UWF retinal mosaic — 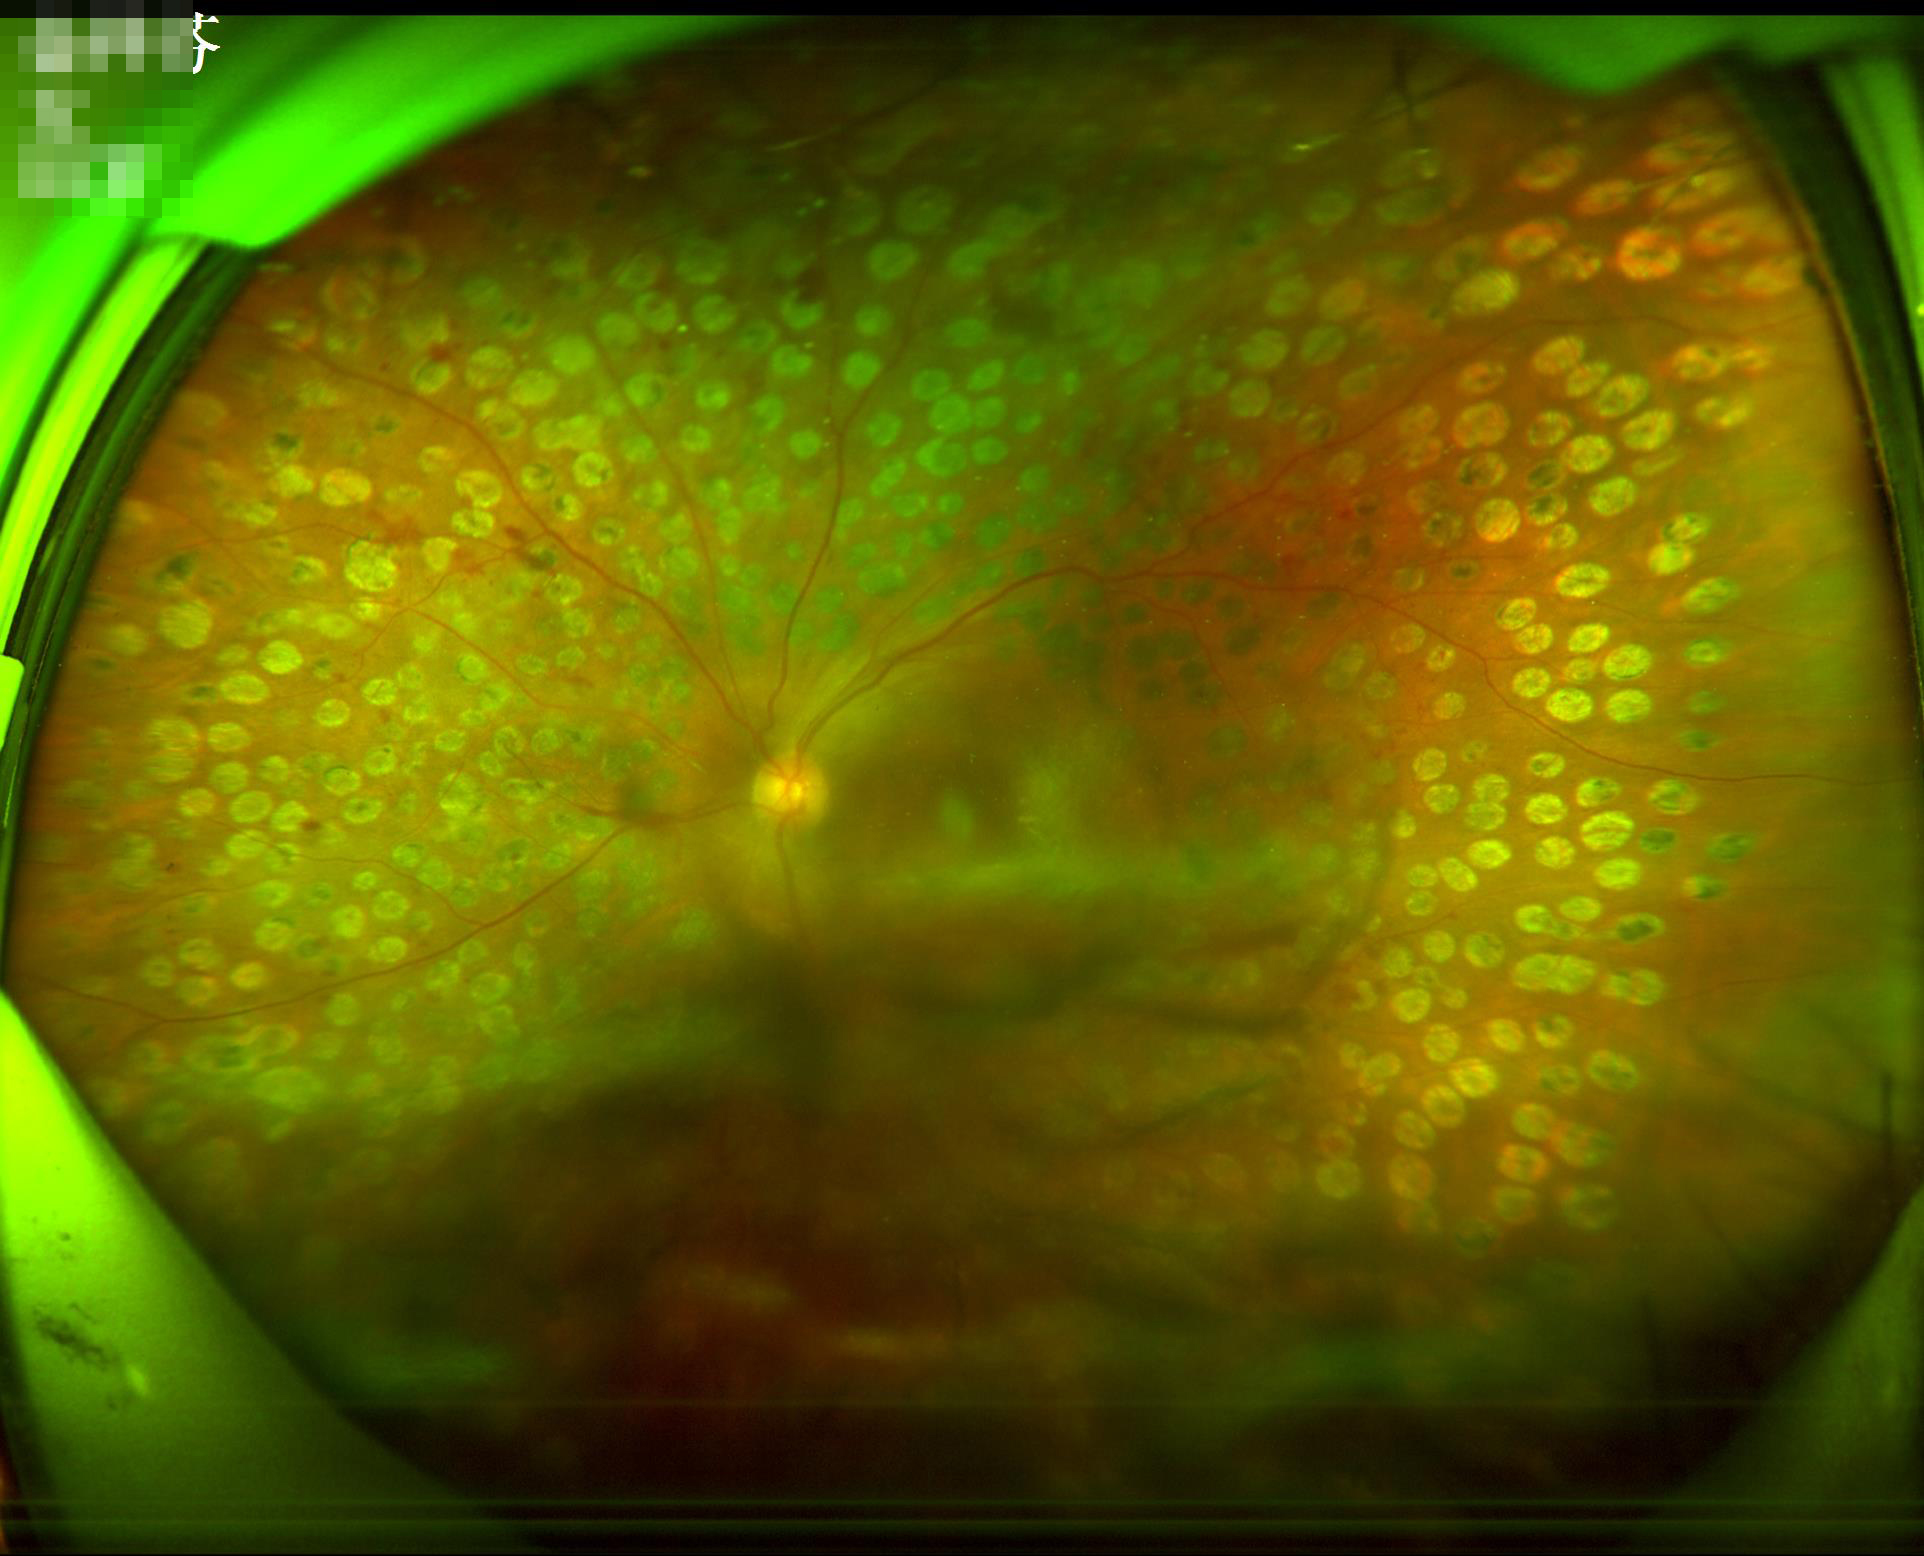

Adequate contrast for distinguishing structures.
Overall quality is poor; the image is difficult to grade.
Illumination and color are suboptimal.
The image is blurry.